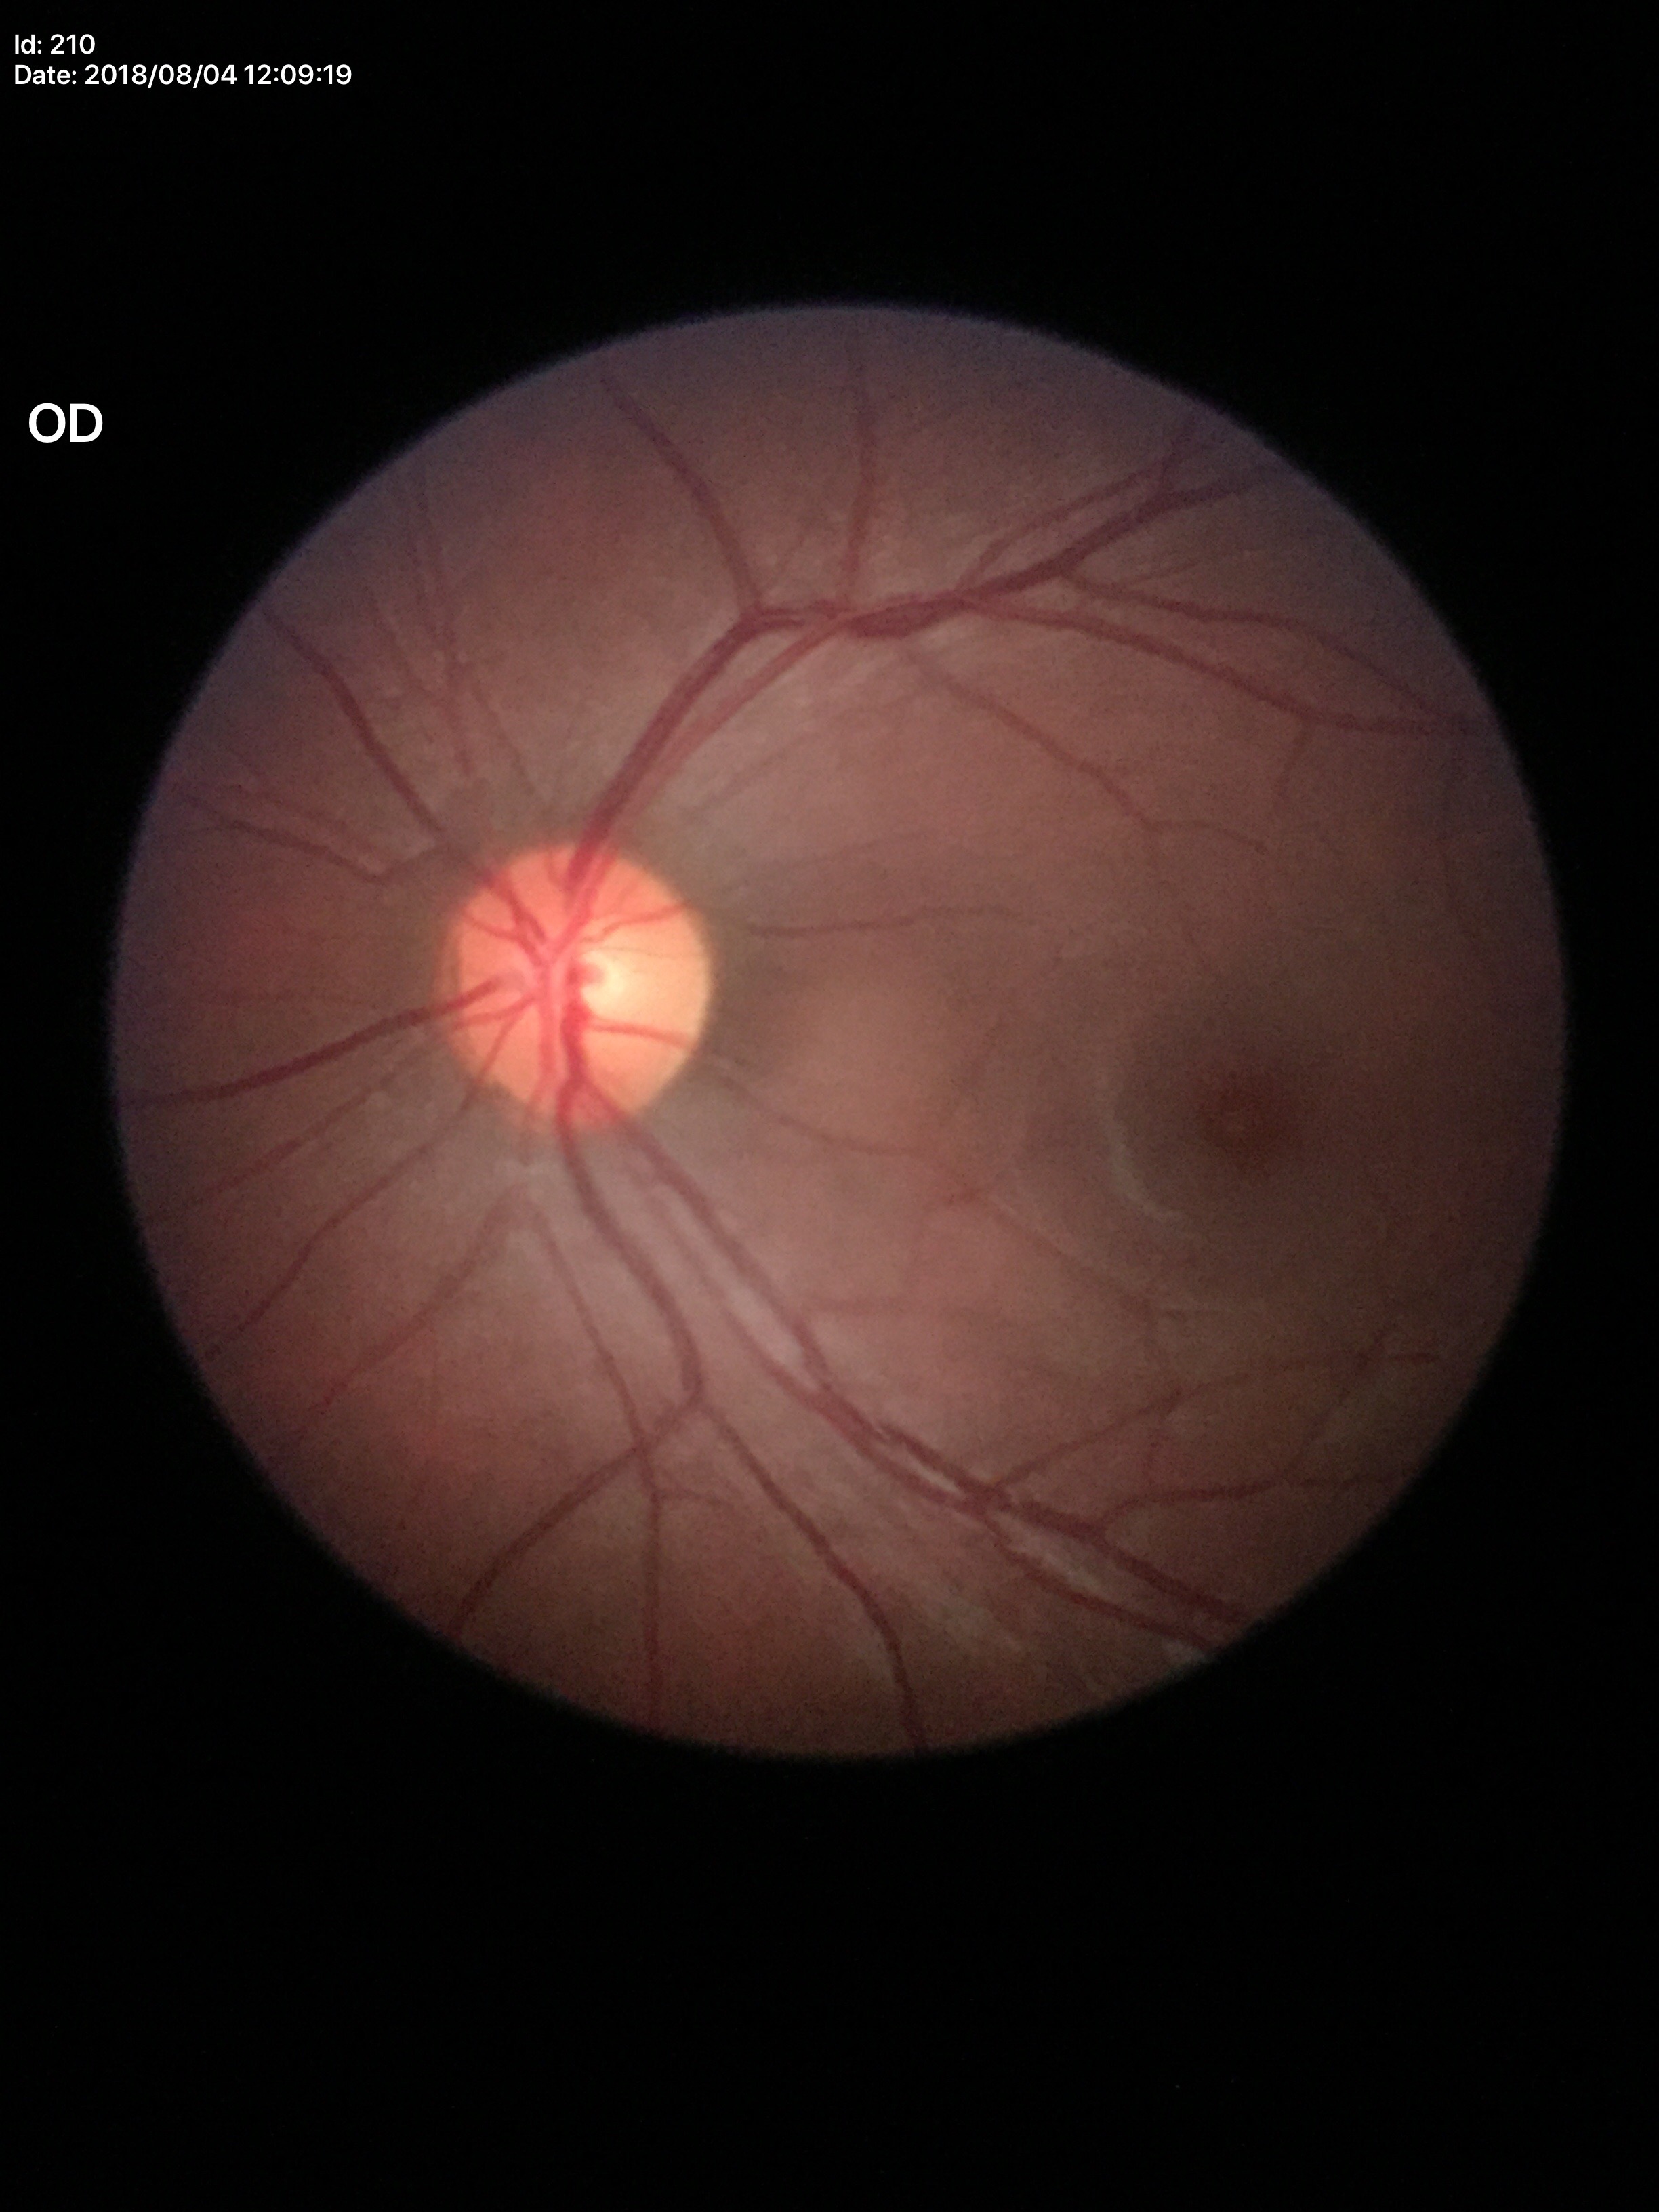 {
  "glaucoma_decision": "not suspect",
  "hcdr": "0.49",
  "vcdr": "0.47"
}